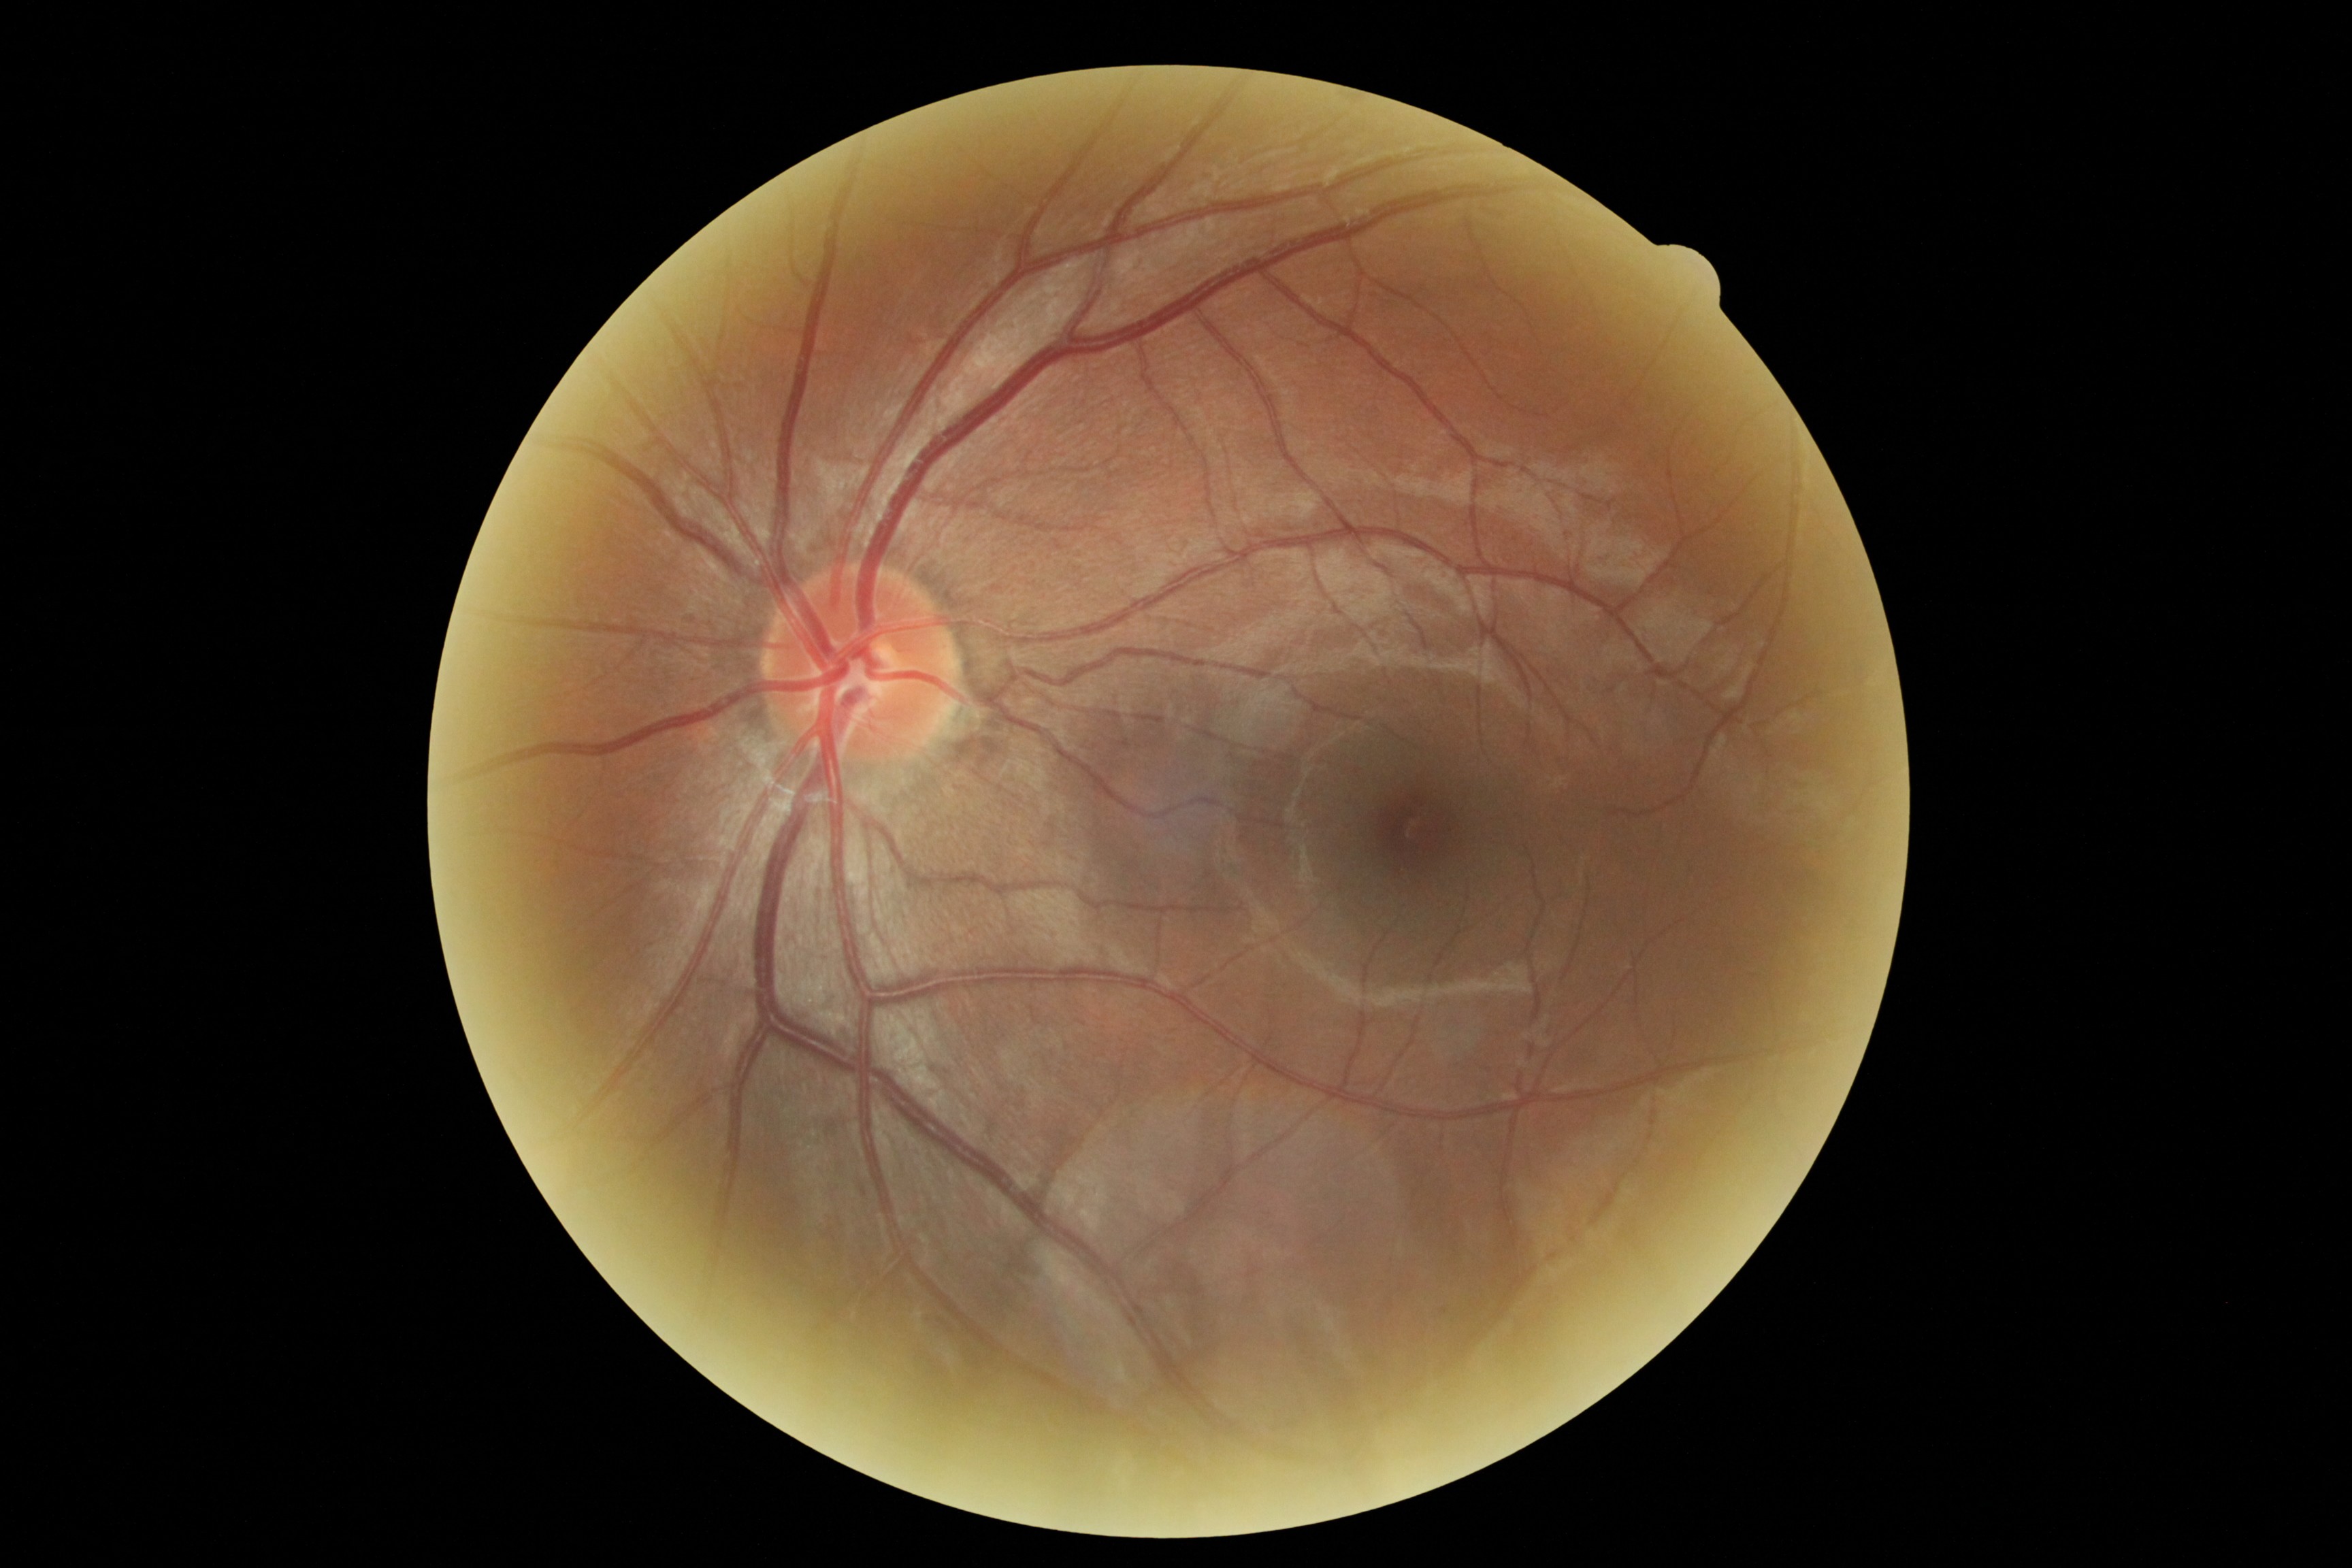
diabetic retinopathy (DR): no apparent diabetic retinopathy (grade 0).